Macula-centered field: 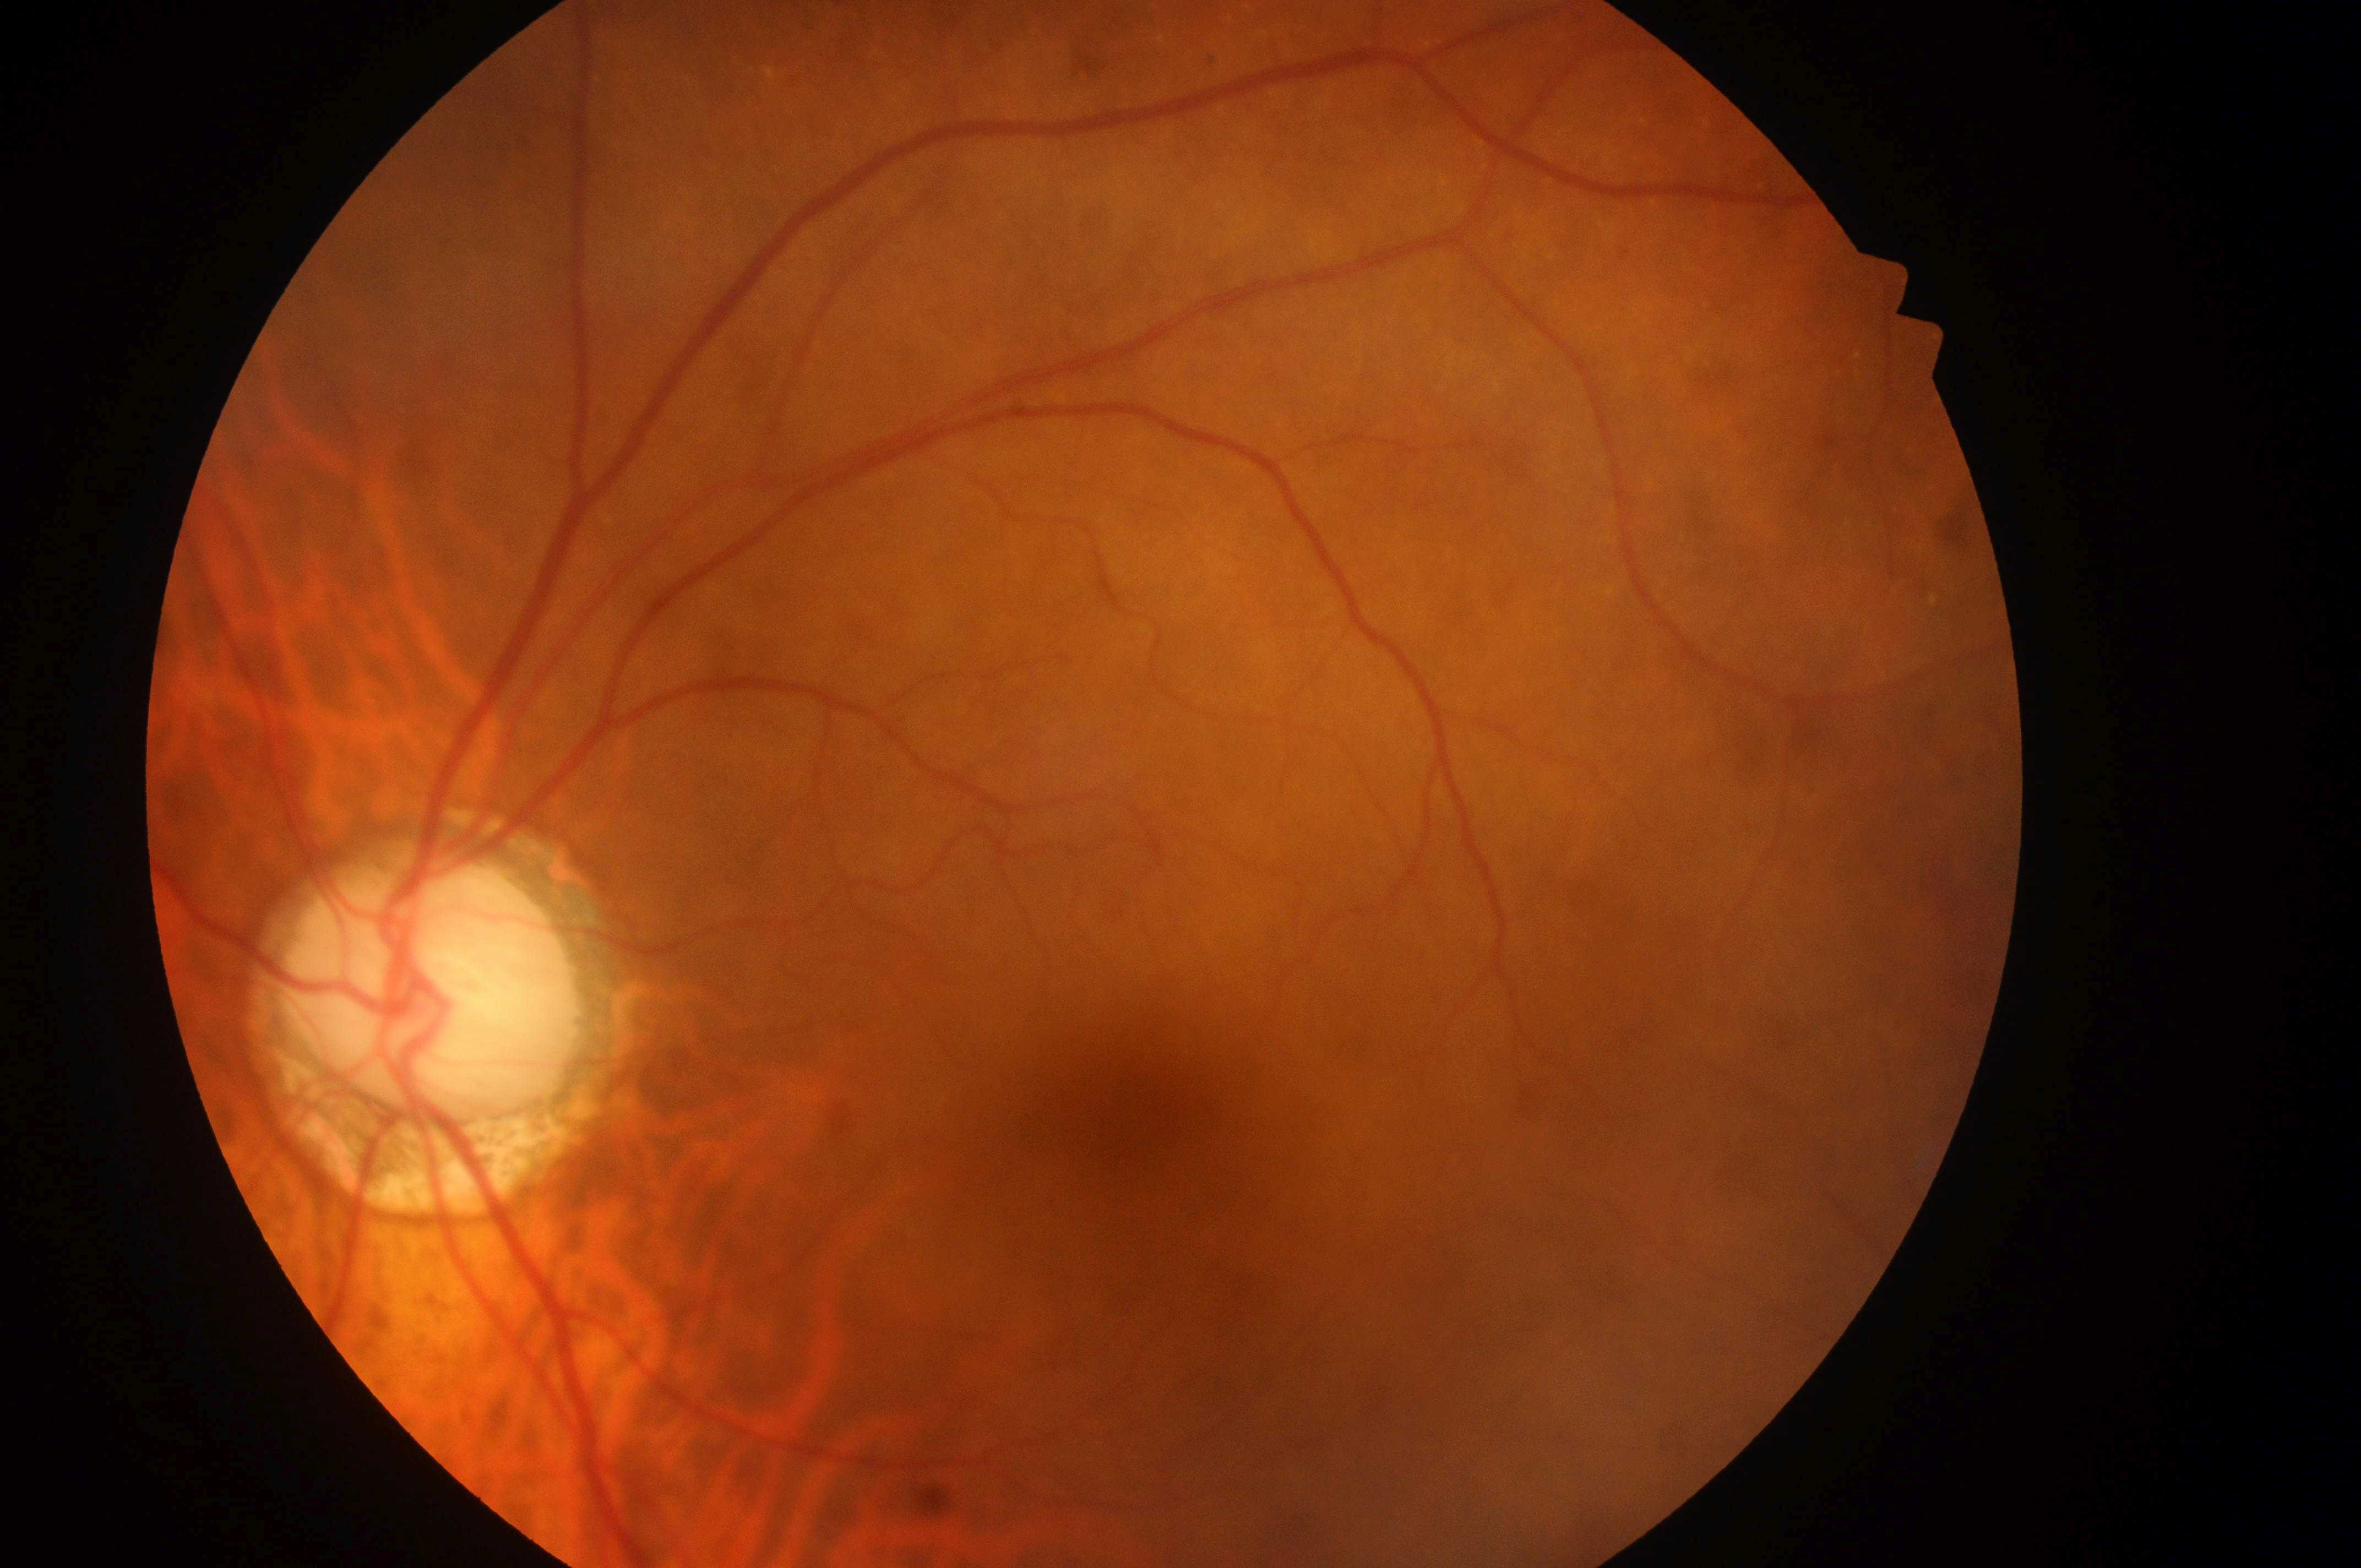

The image shows the left eye.
Fovea located at x=1130, y=1124.
Optic disc center: x=439, y=998.
Diabetic macular edema (DME) is 0/2.
Diabetic retinopathy (DR): grade 0.
No DR or DME findings.